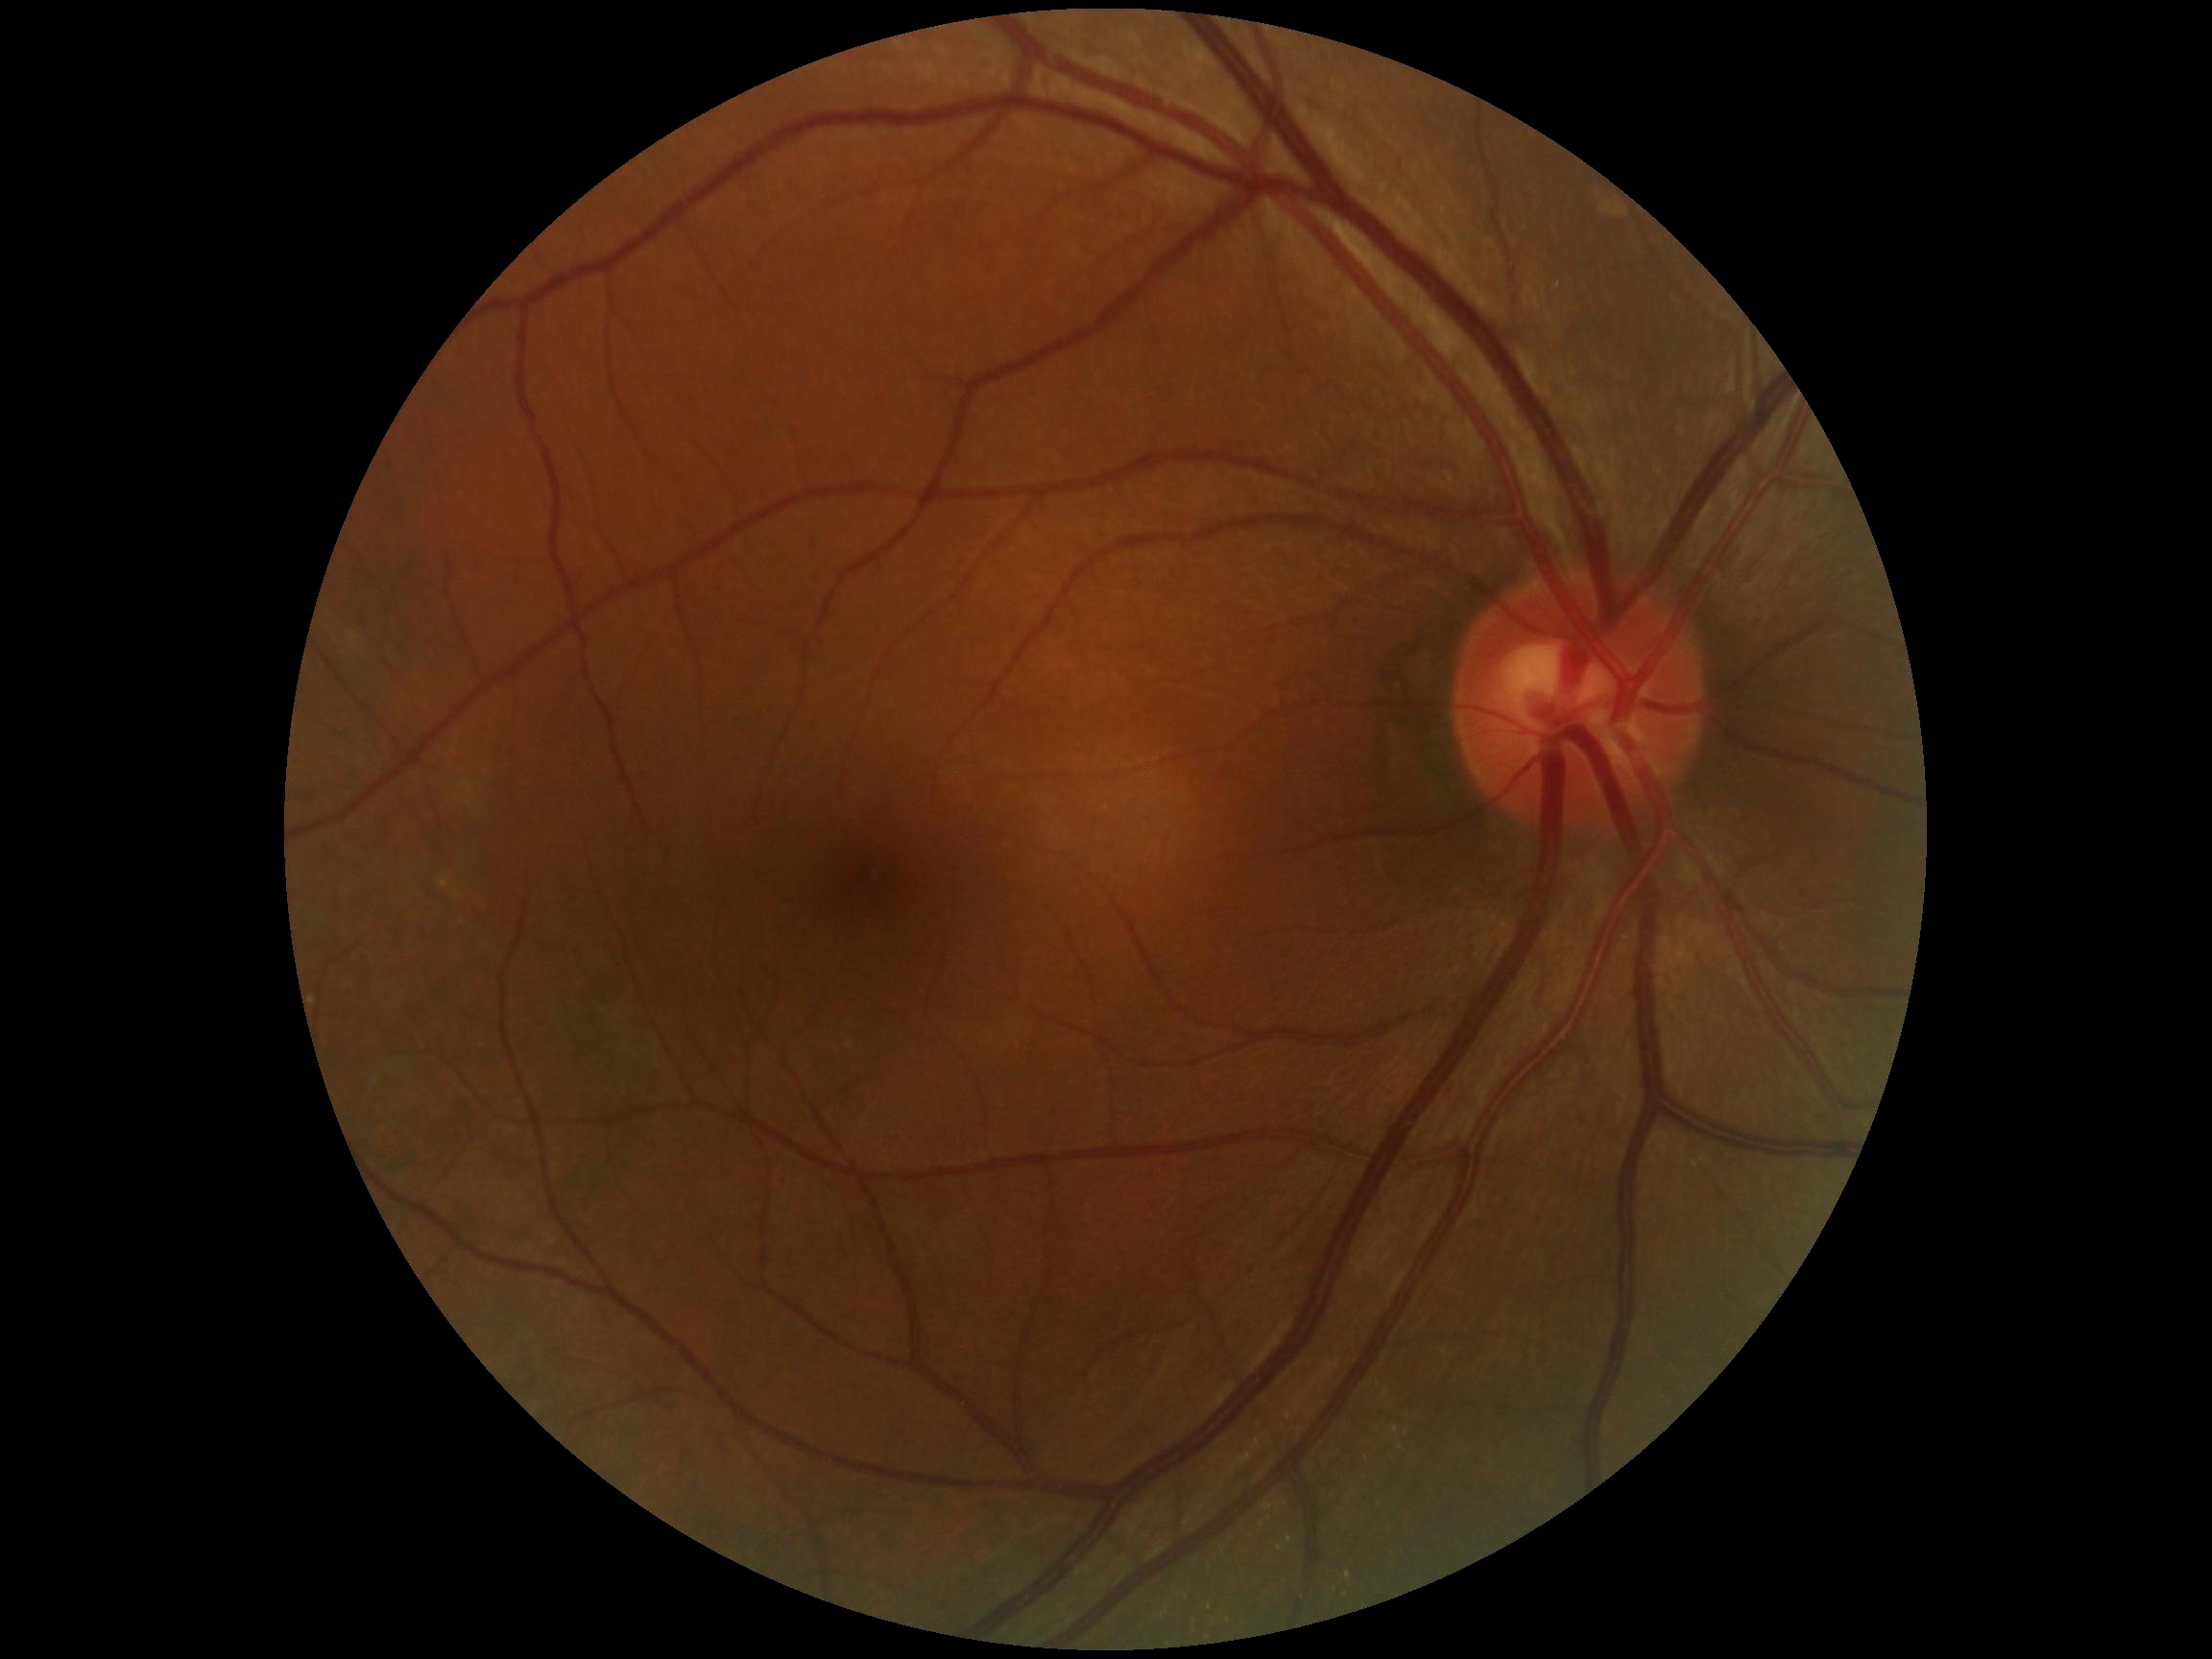 diabetic retinopathy=grade 0 (no apparent retinopathy).